Ultra-widefield fundus mosaic:
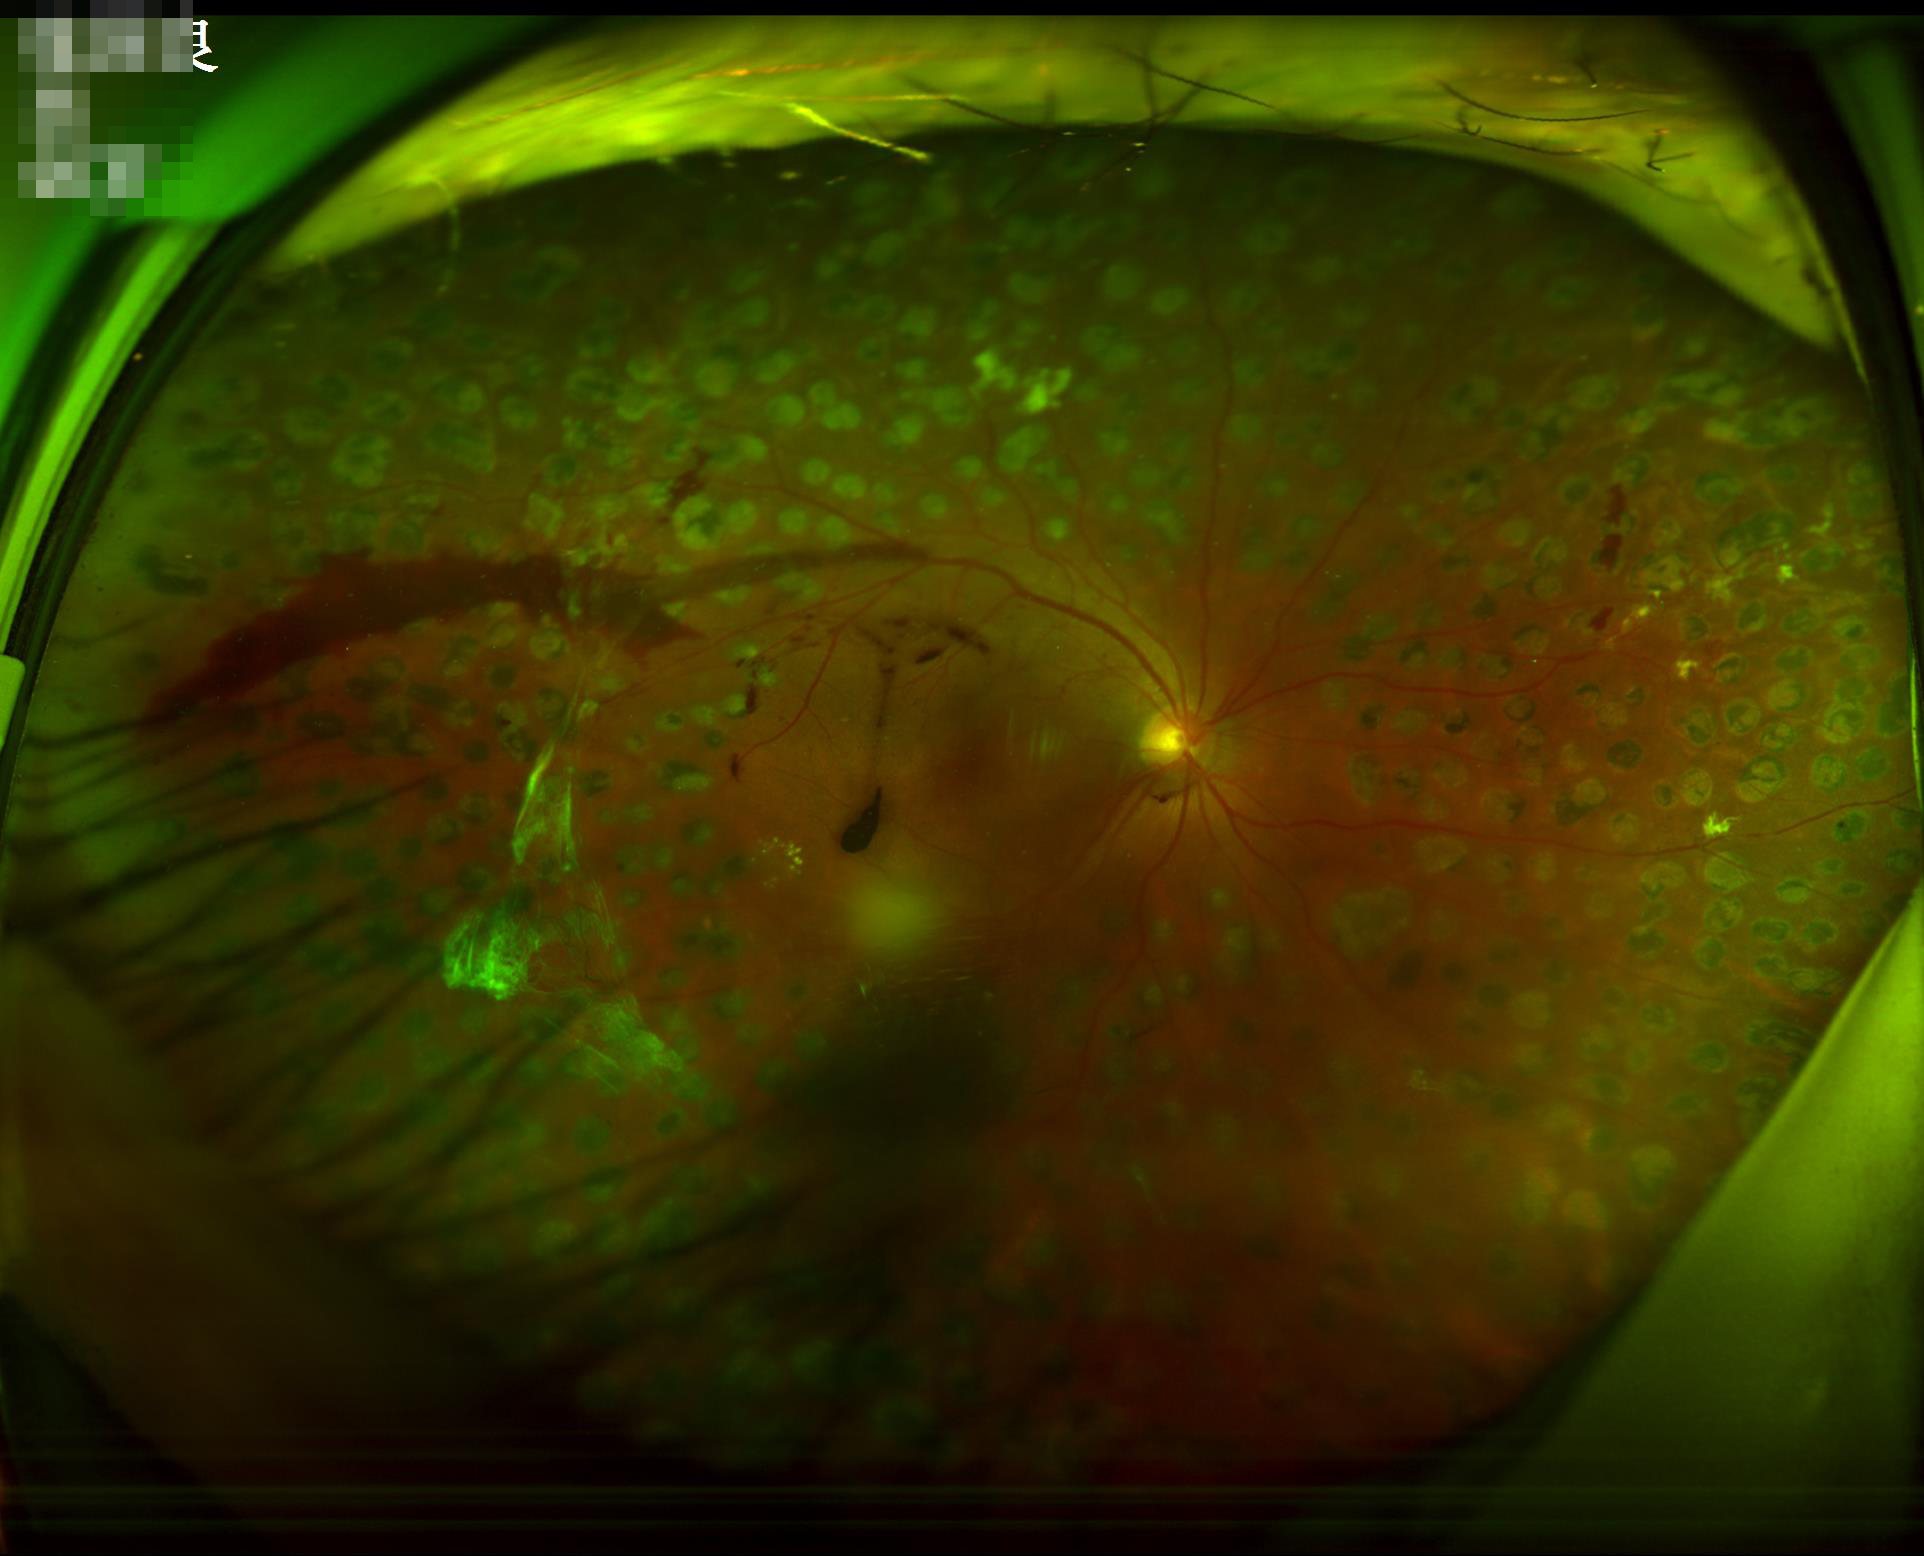 Illumination/color: uniform, no color cast
Sharpness: reduced sharpness with visible blur
Overall image quality: inadequate for clinical interpretation